Image size 2361x1568:
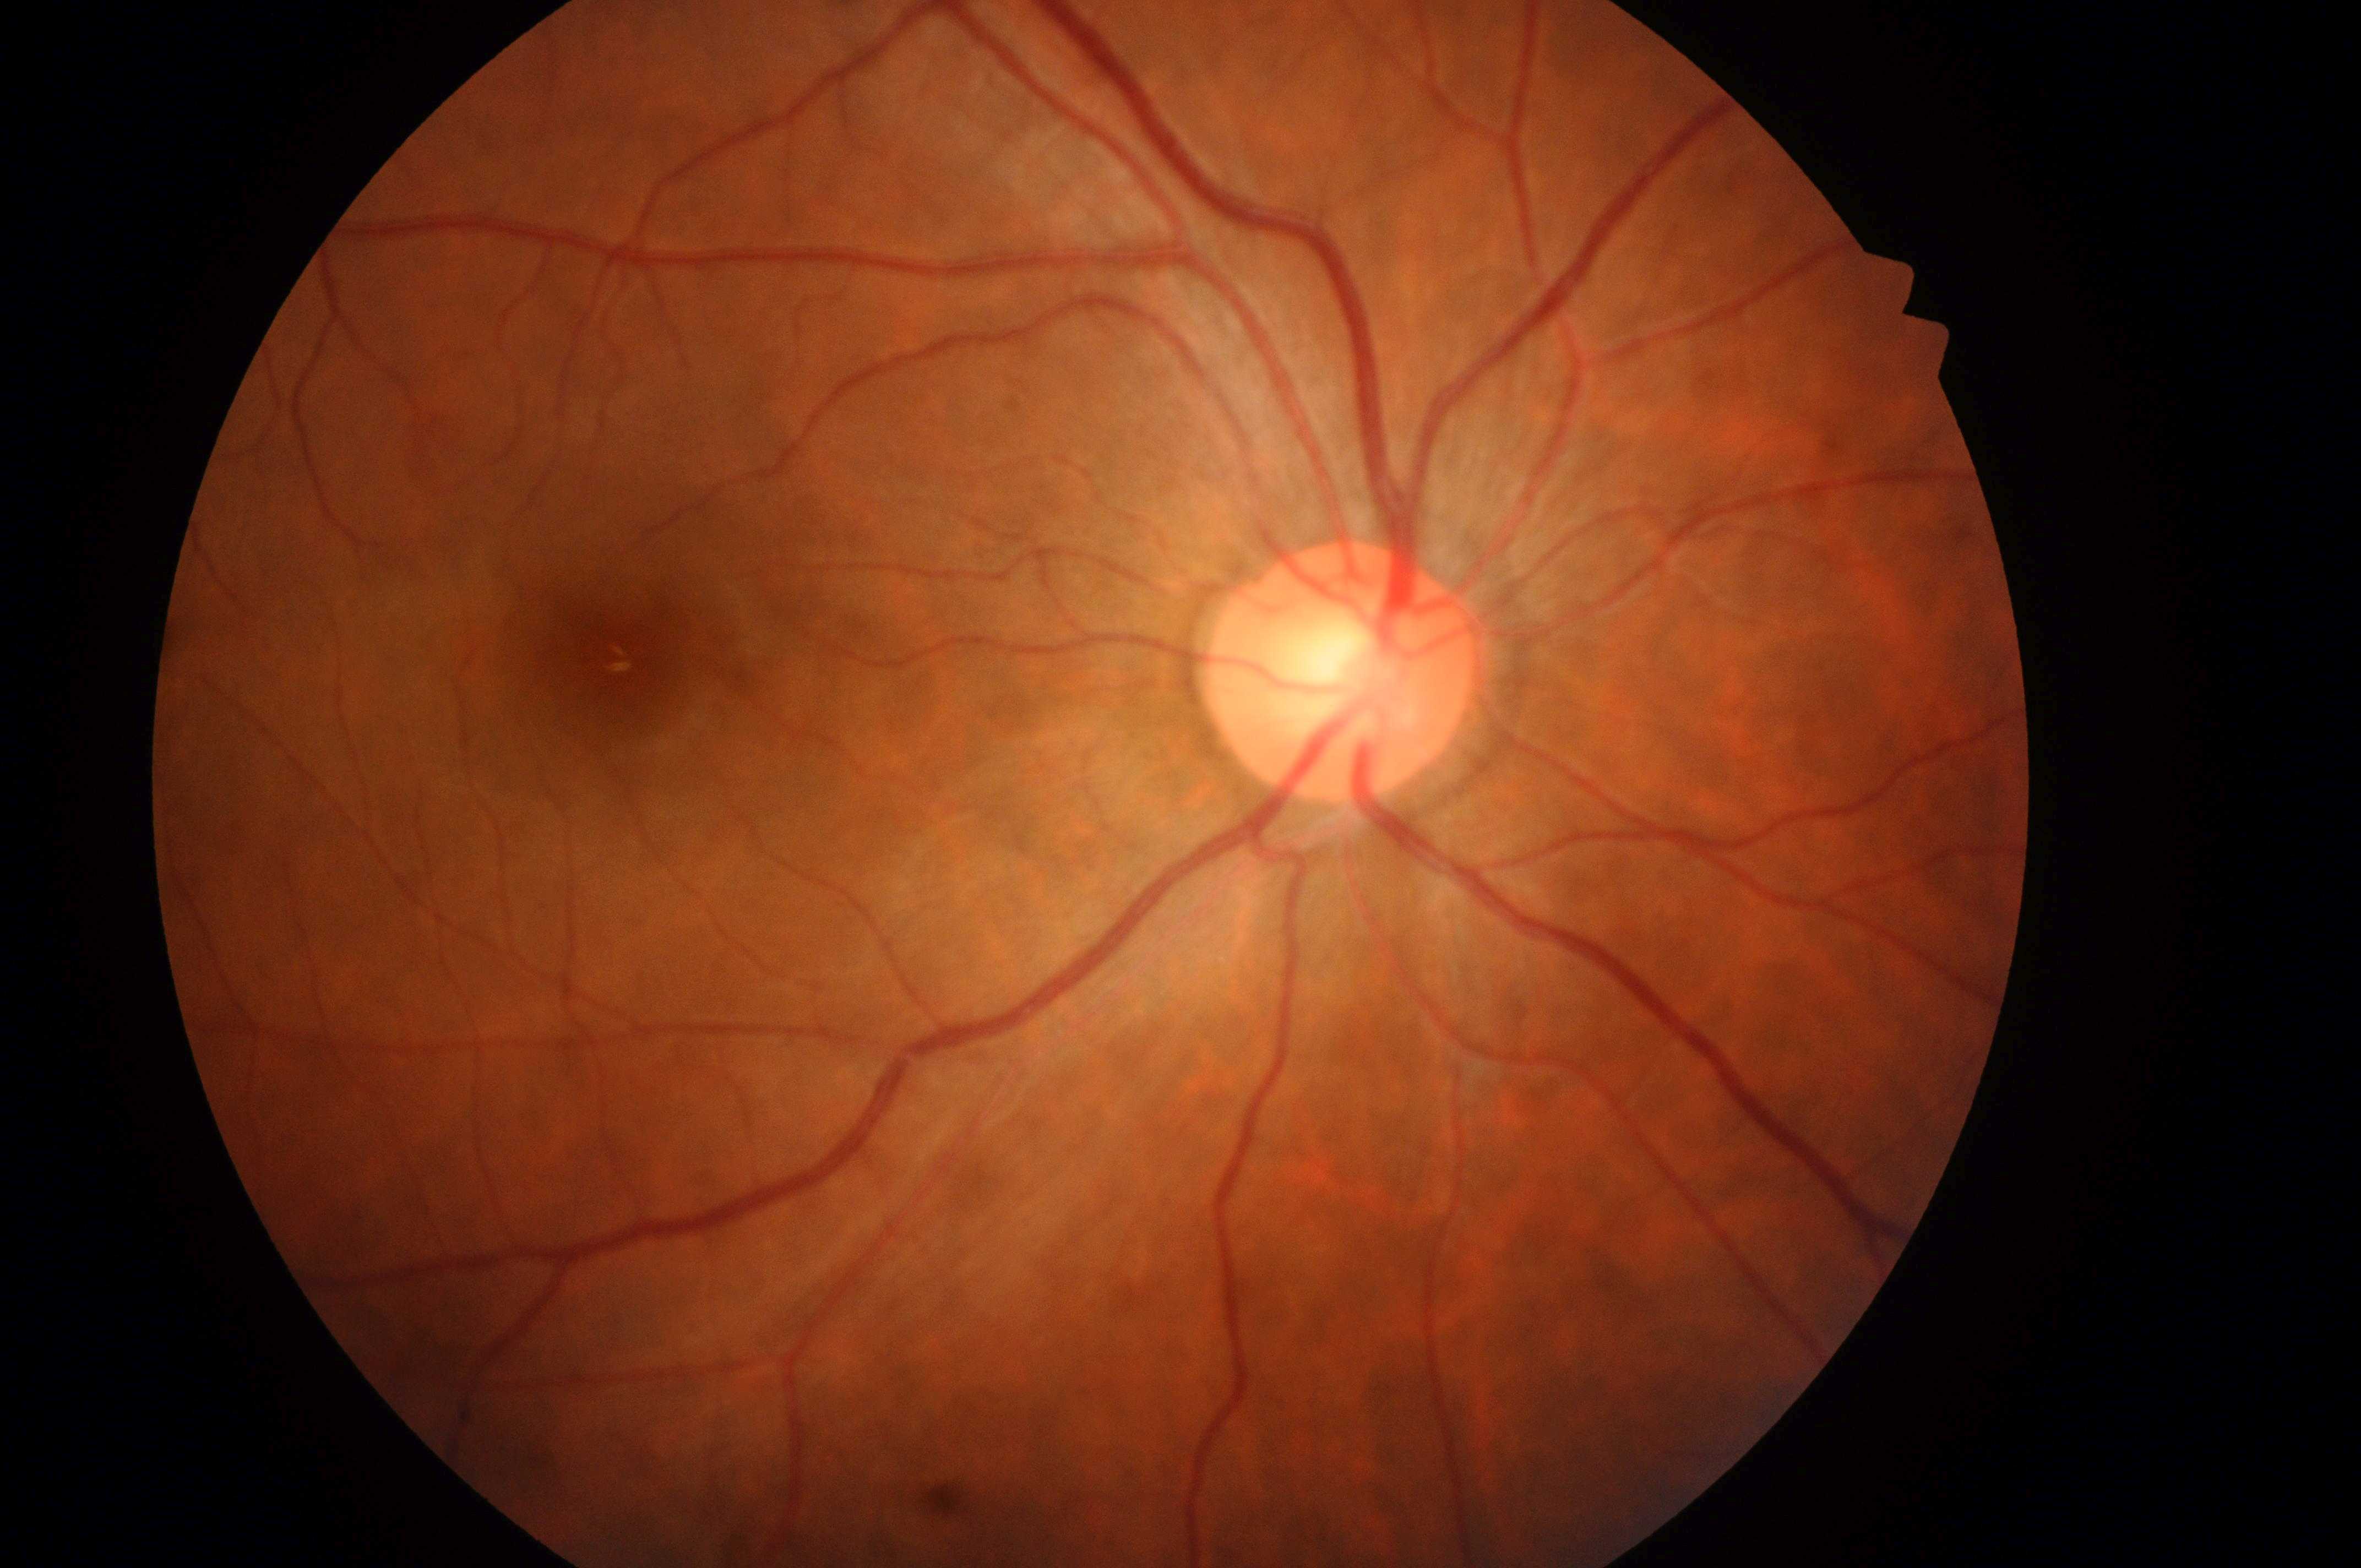

Q: Which eye is imaged?
A: the right eye
Q: DR stage?
A: grade 0 — no visible signs of diabetic retinopathy
Q: Locate the fovea.
A: 602px, 660px
Q: DME grade?
A: 0 — no apparent hard exudates
Q: Locate the optic disc.
A: 1336px, 684px